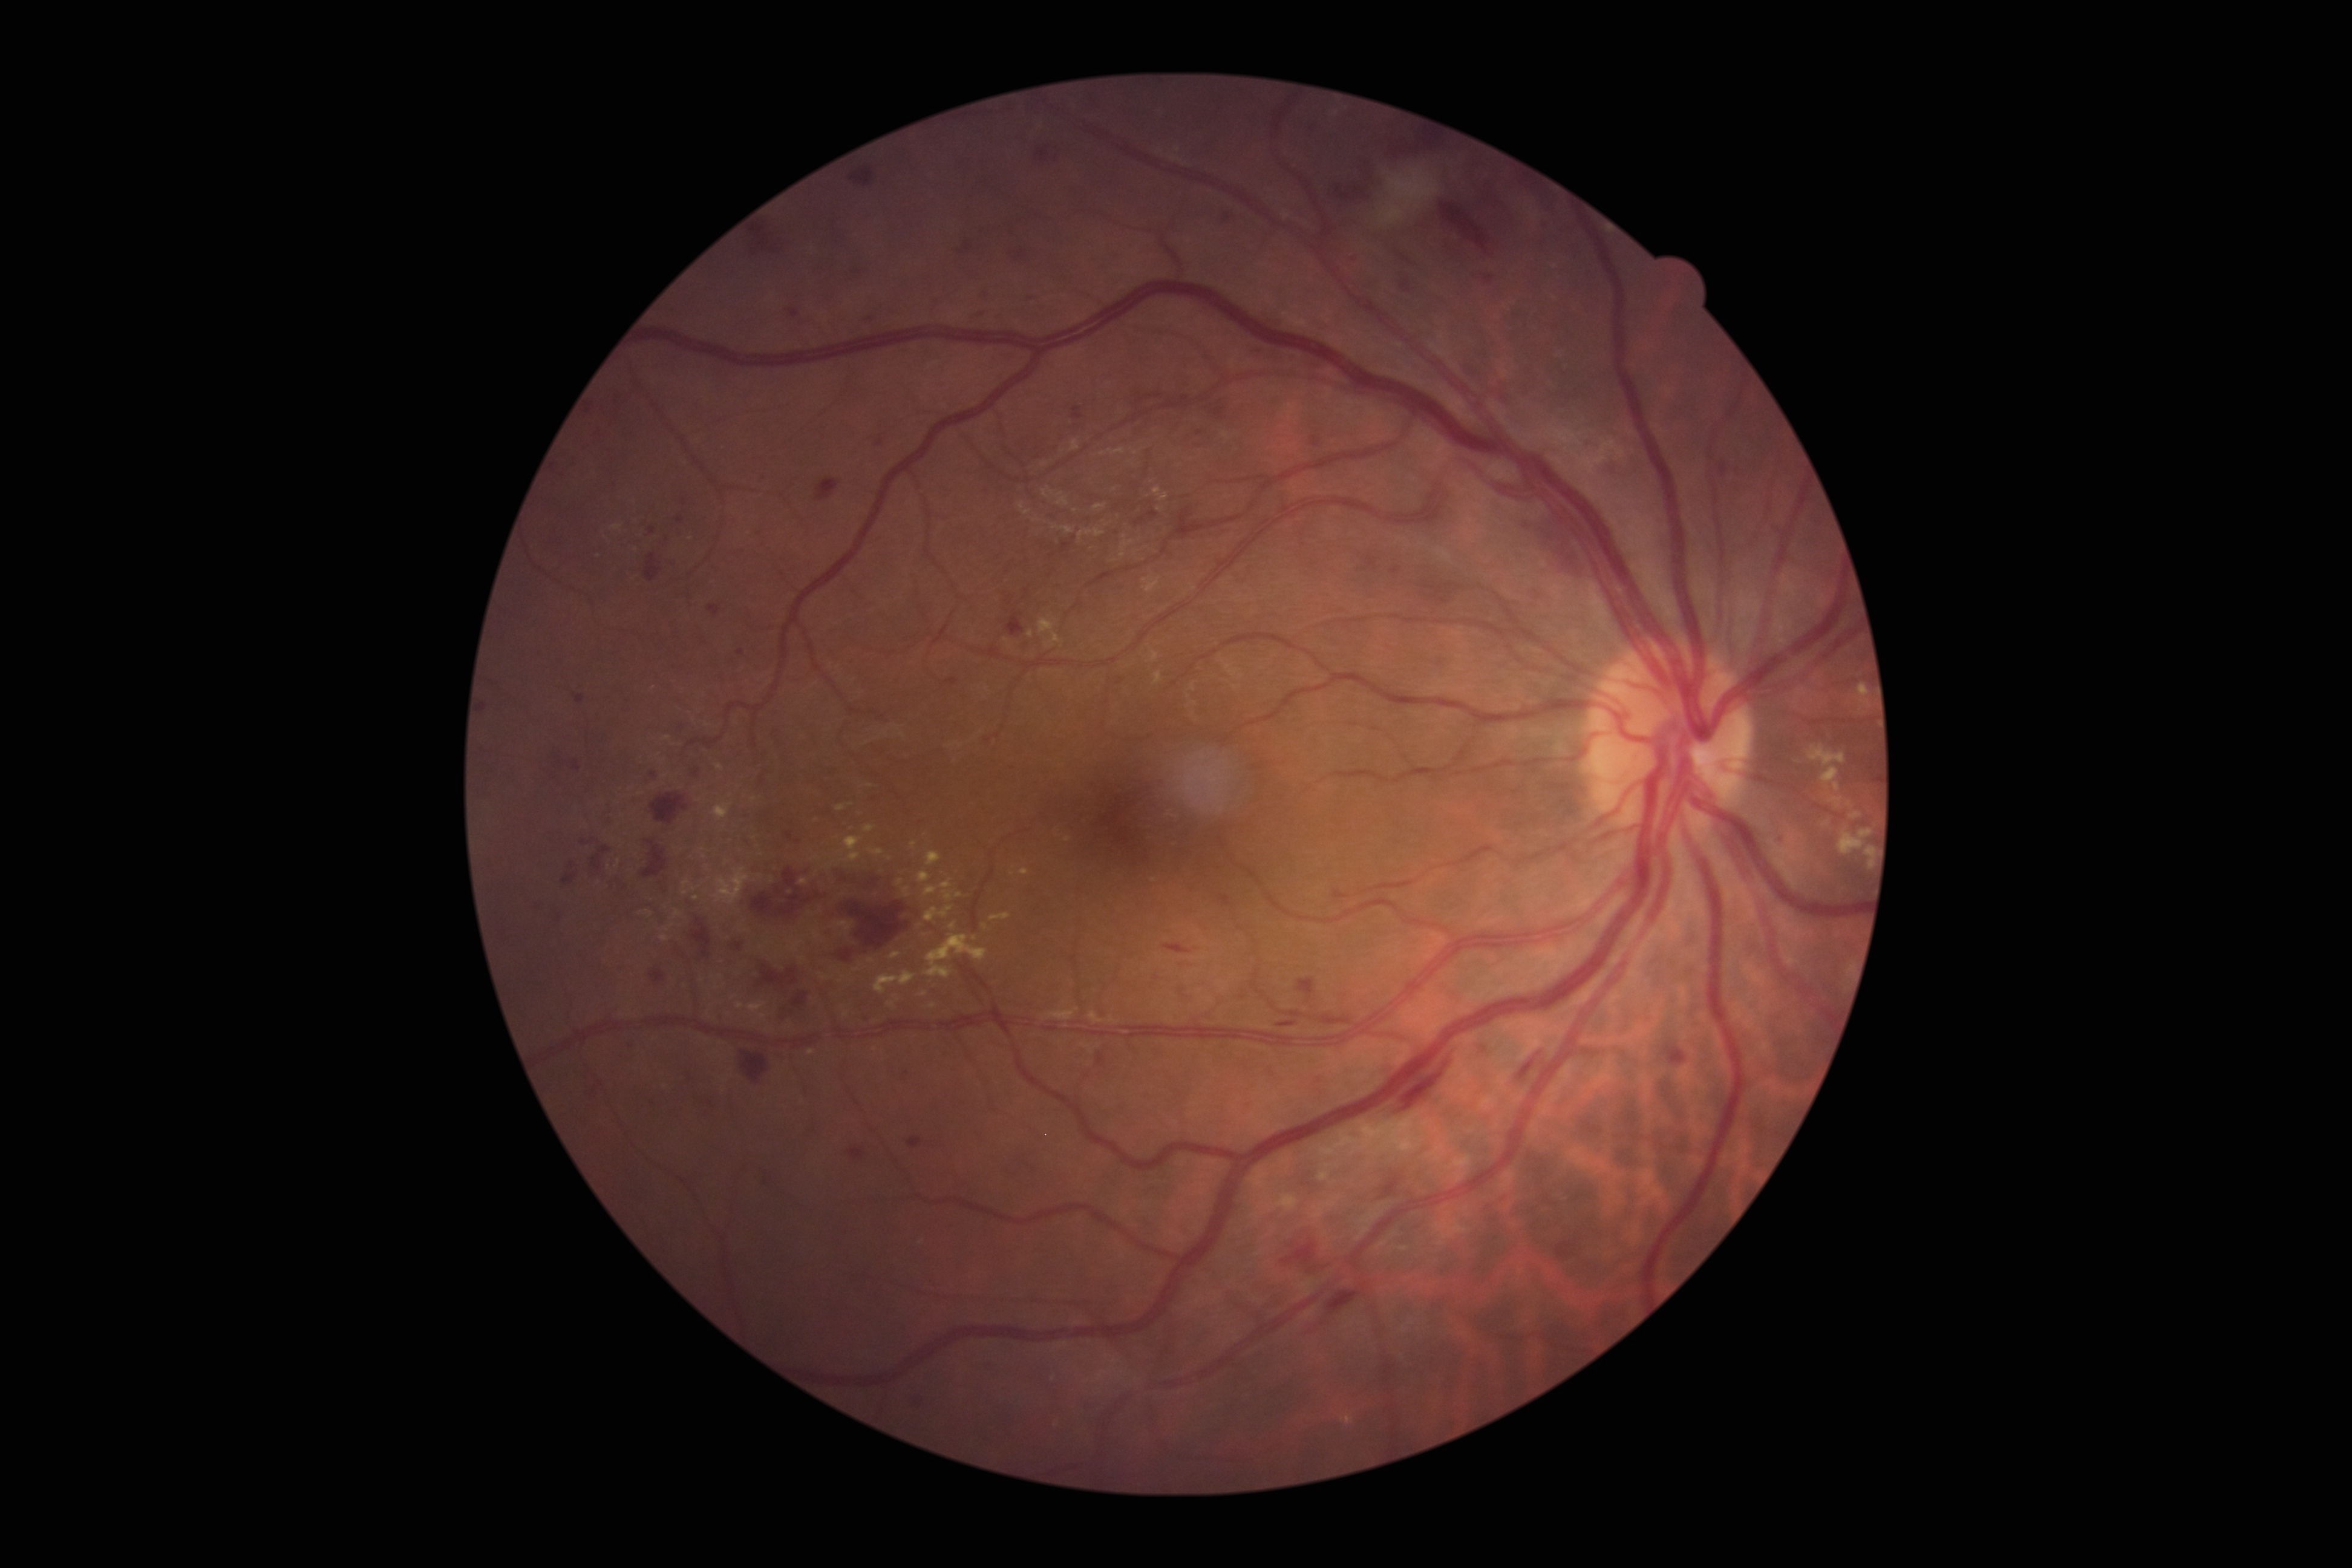
Retinopathy grade: 3/4.